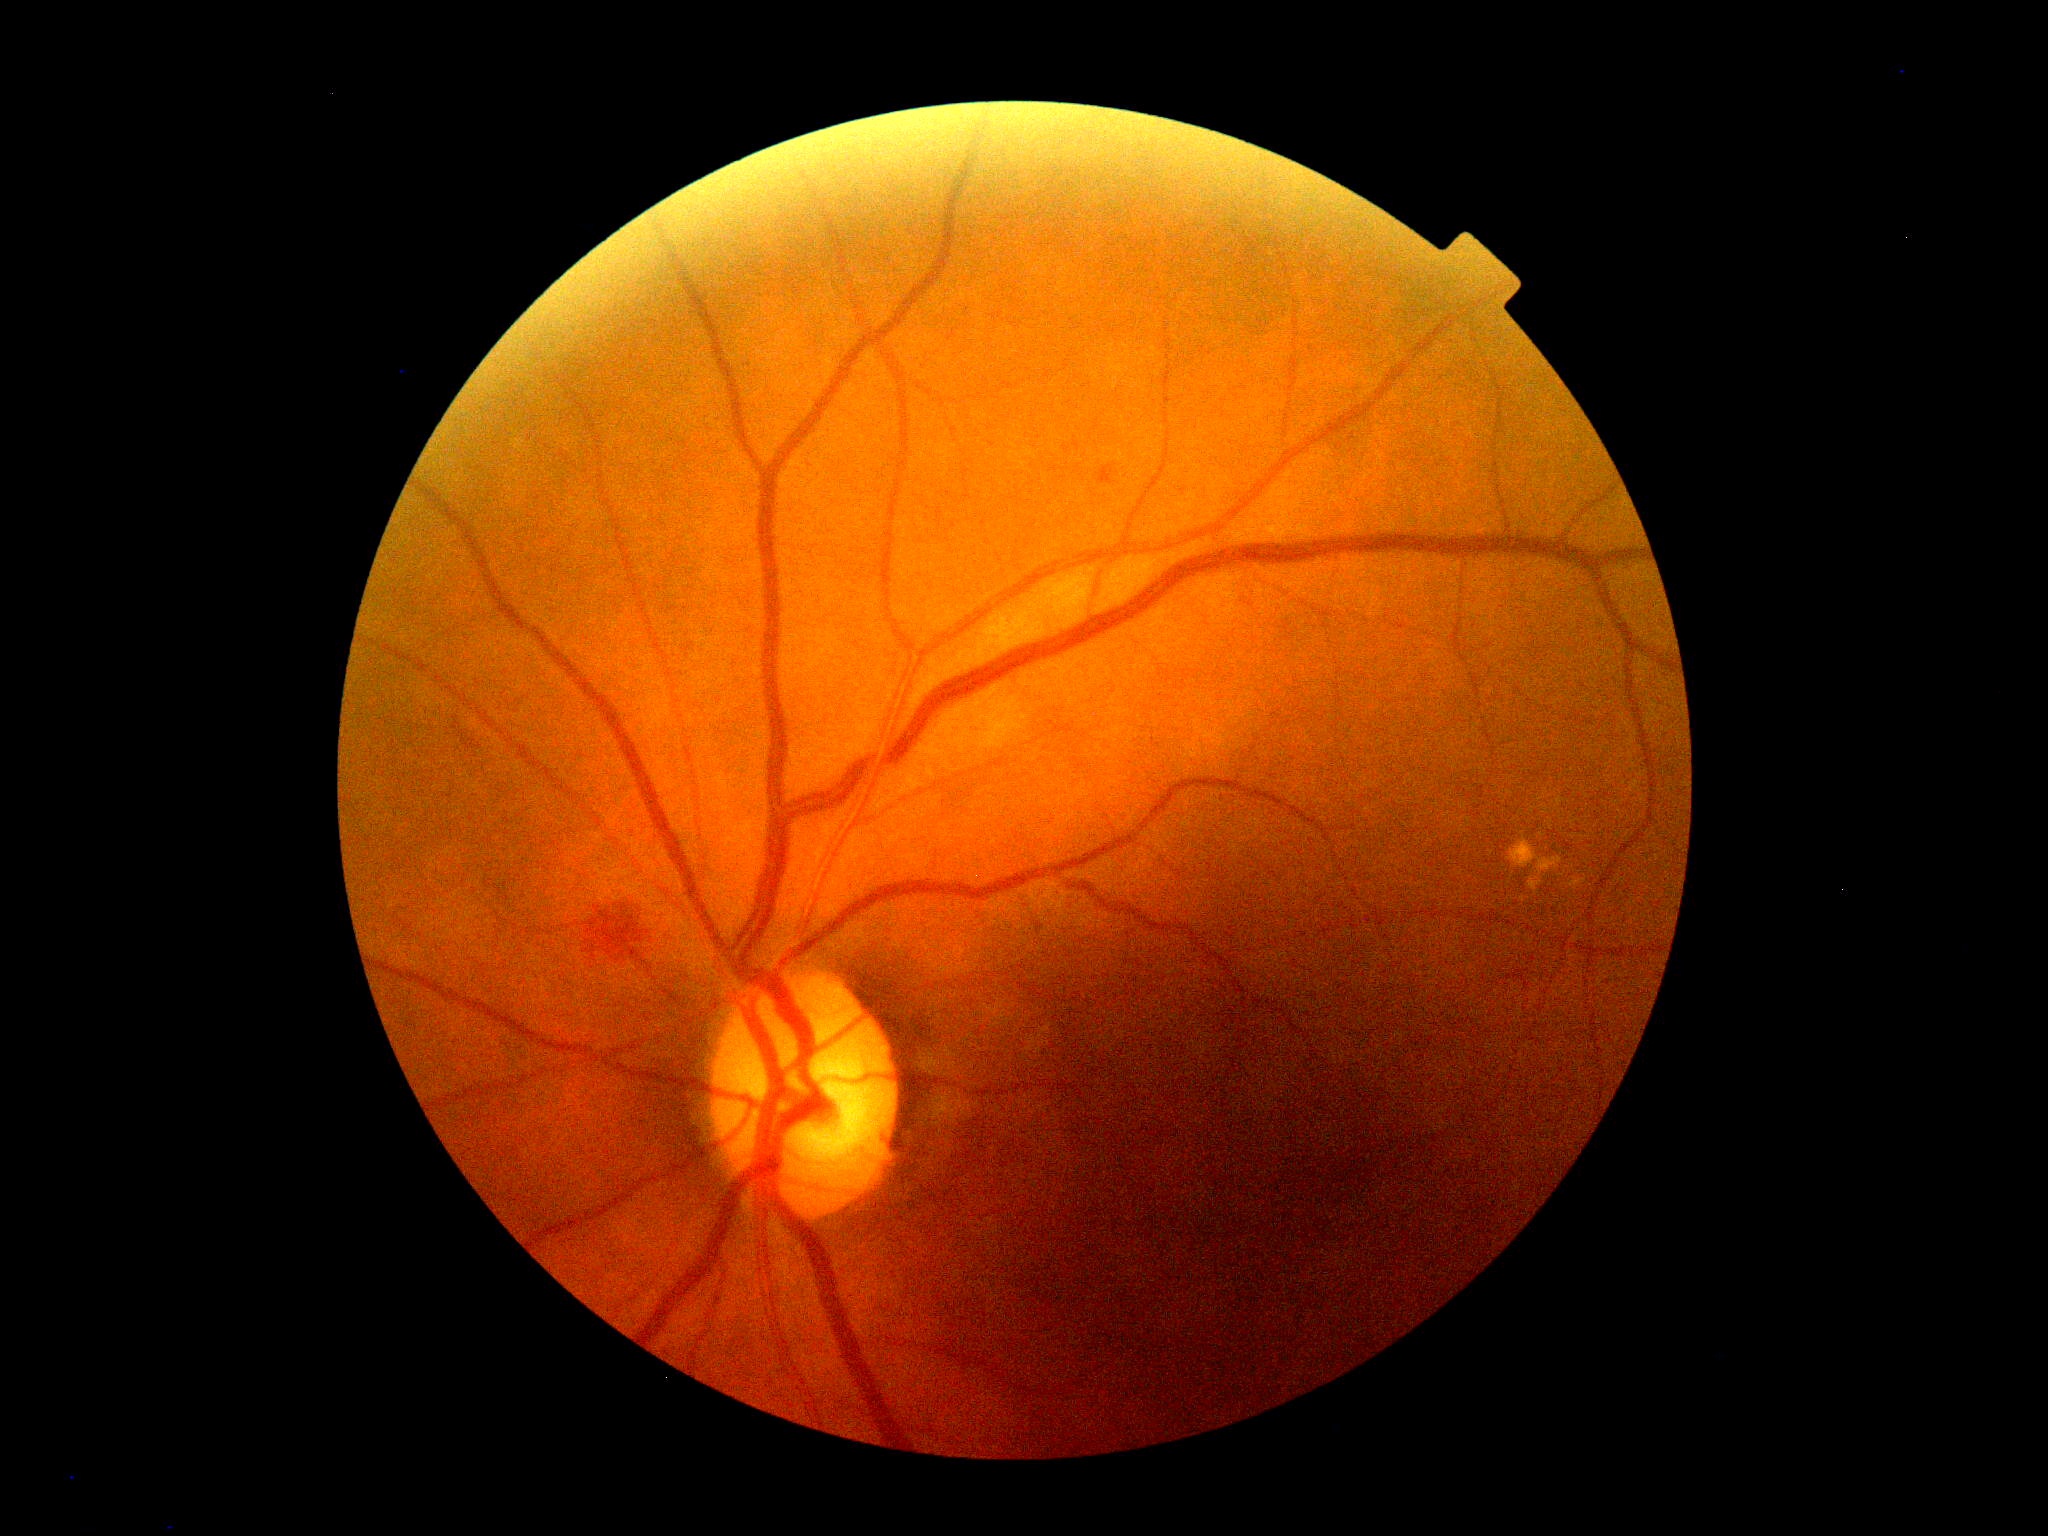

Annotations:
– DR class — non-proliferative diabetic retinopathy
– diabetic retinopathy grade — 2 (moderate NPDR)